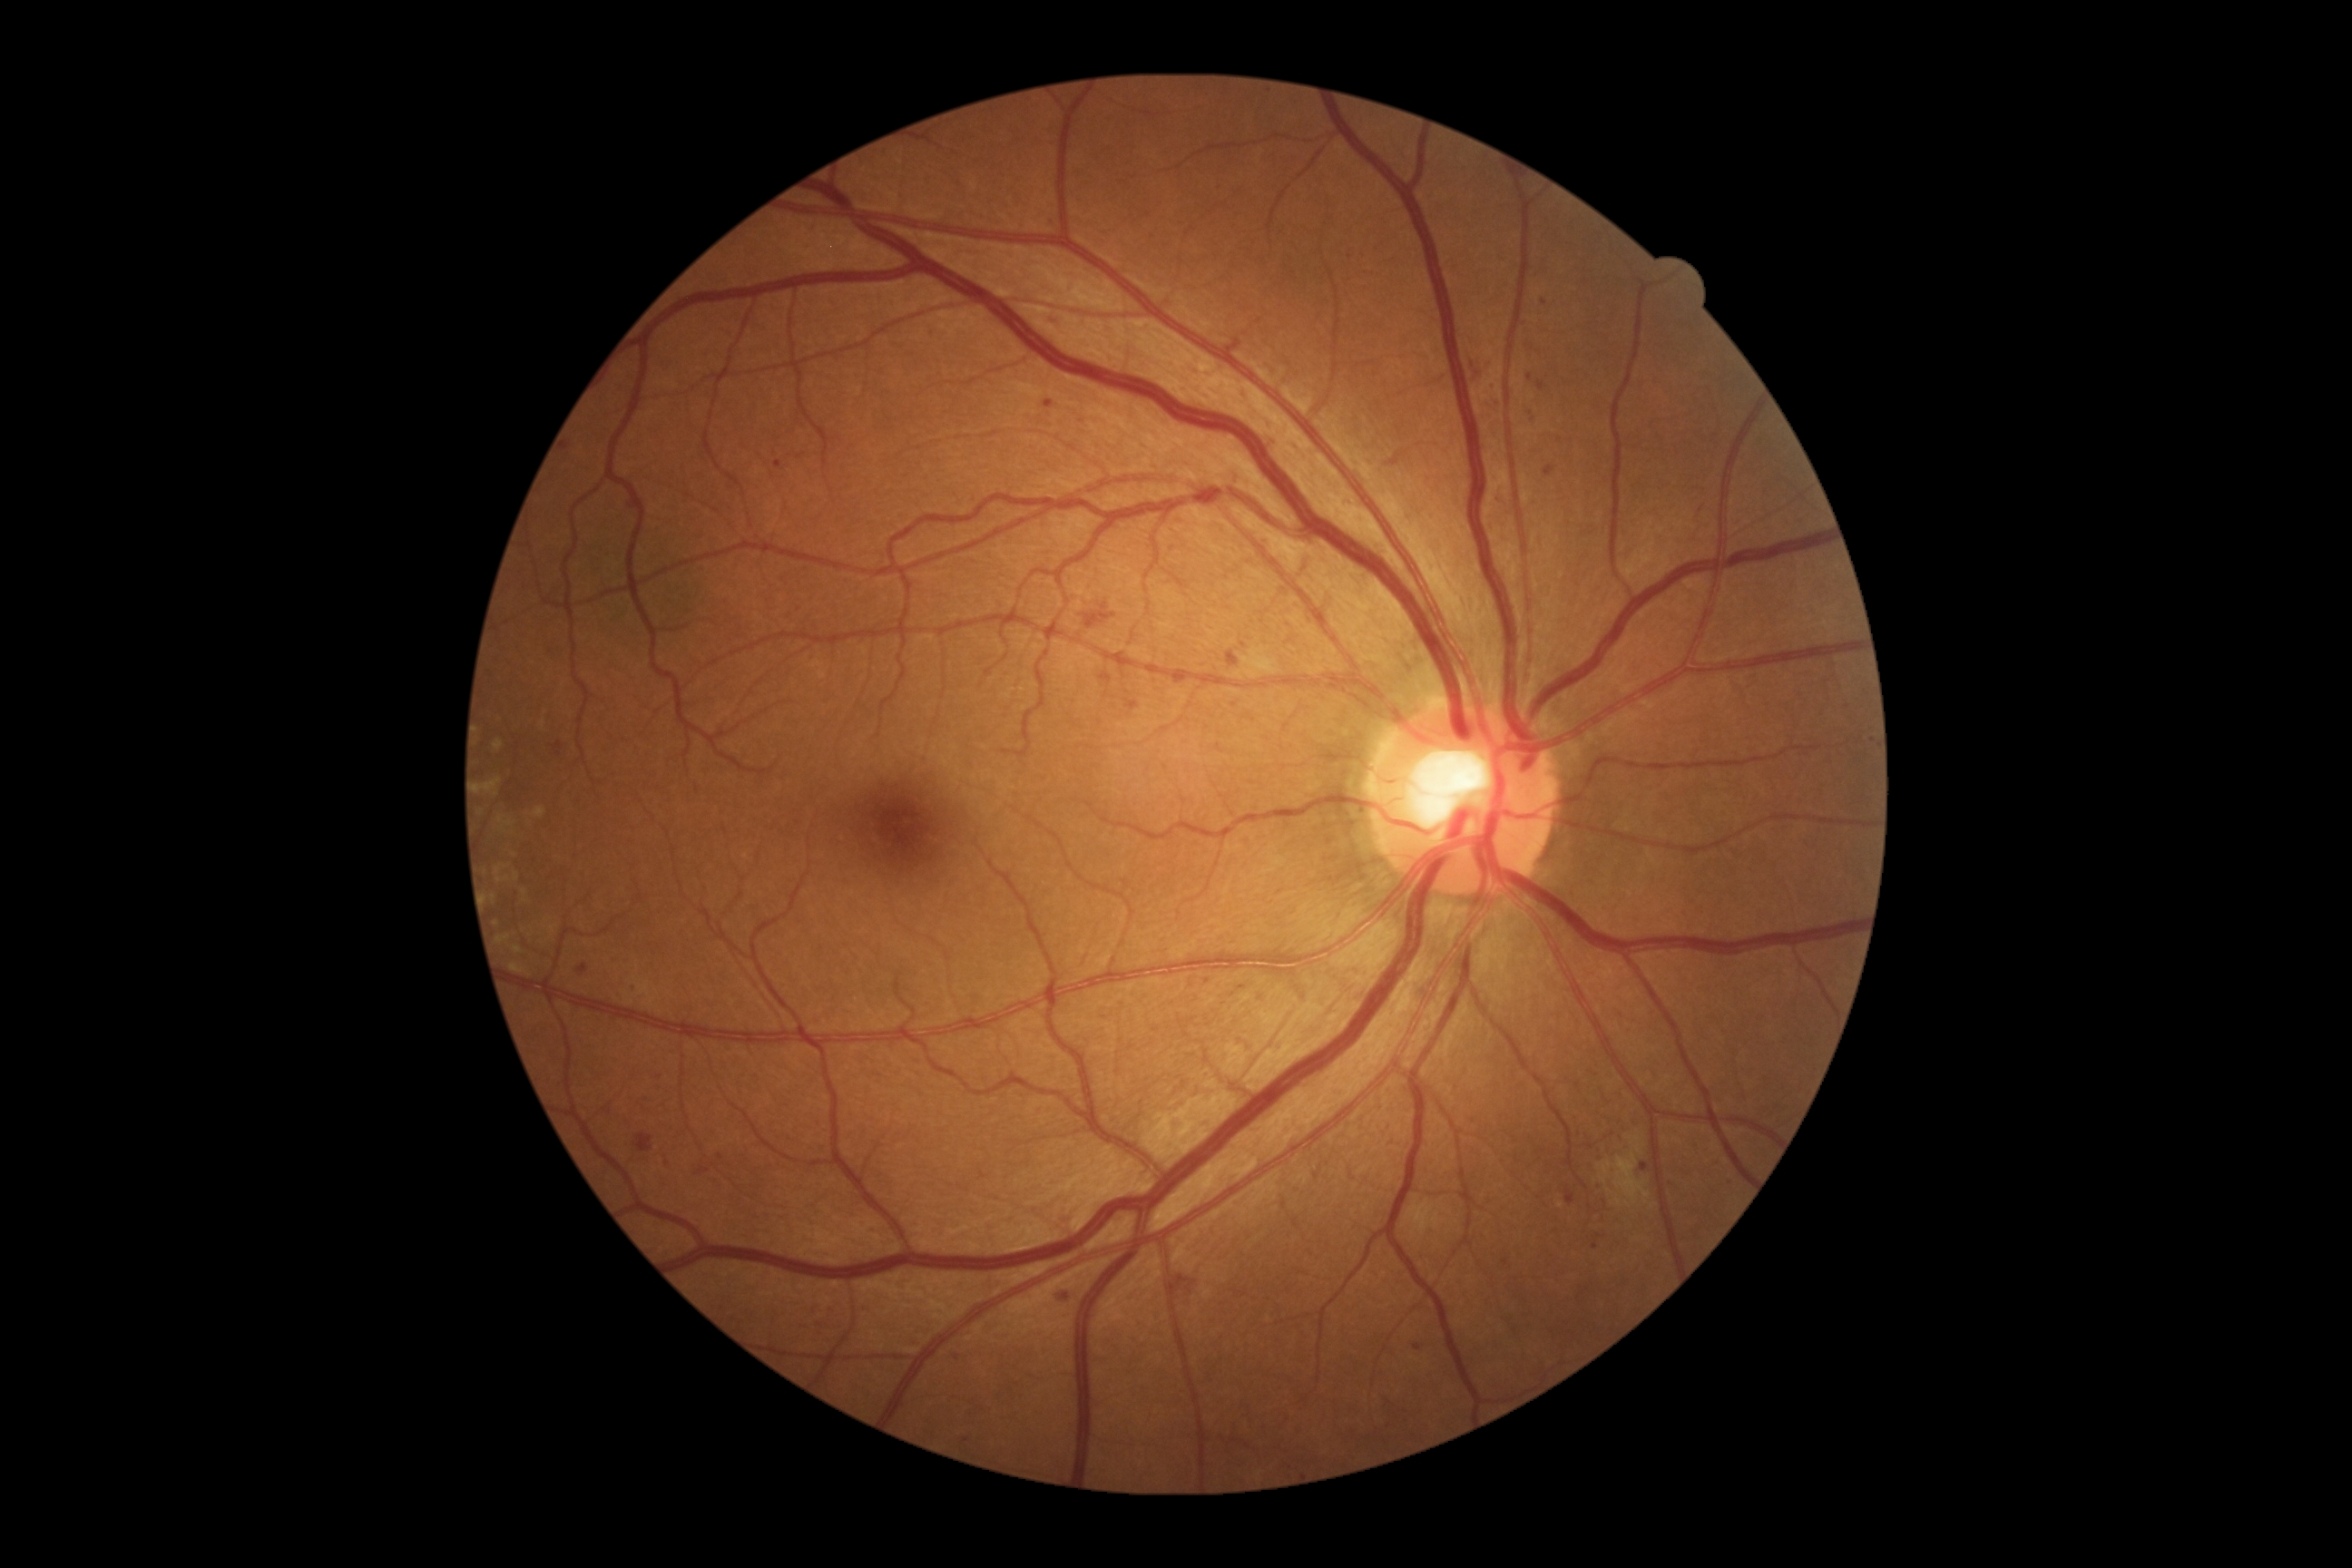 partial: true
dr_grade: 2
lesions:
  se:
    - x1=1596 y1=1153 x2=1651 y2=1206
    - x1=1611 y1=1199 x2=1623 y2=1208
    - x1=1627 y1=1135 x2=1643 y2=1155
  se_small_approx:
    - <point>1652, 1206</point>
    - <point>1628, 1205</point>
    - <point>1609, 1191</point>
  he:
    - x1=1469 y1=357 x2=1496 y2=384
    - x1=1386 y1=451 x2=1409 y2=467
    - x1=634 y1=1133 x2=654 y2=1153
    - x1=1083 y1=603 x2=1117 y2=629
    - x1=1173 y1=1271 x2=1199 y2=1304
  ma:
    - x1=1545 y1=466 x2=1554 y2=478
    - x1=1050 y1=313 x2=1066 y2=328
    - x1=1099 y1=674 x2=1112 y2=683
    - x1=1565 y1=1190 x2=1574 y2=1204
    - x1=1055 y1=1289 x2=1070 y2=1304
    - x1=1493 y1=395 x2=1502 y2=406
    - x1=1592 y1=1244 x2=1600 y2=1250
    - x1=1538 y1=382 x2=1545 y2=391
    - x1=1126 y1=700 x2=1141 y2=710
  ma_small_approx:
    - <point>1531, 377</point>
    - <point>967, 1440</point>
    - <point>1645, 1167</point>
    - <point>1281, 893</point>
  ex:
    - x1=514 y1=872 x2=520 y2=881
    - x1=514 y1=946 x2=522 y2=954
    - x1=480 y1=778 x2=502 y2=798
    - x1=493 y1=741 x2=504 y2=752
    - x1=534 y1=807 x2=547 y2=819
    - x1=496 y1=867 x2=504 y2=876
    - x1=498 y1=936 x2=511 y2=945
    - x1=549 y1=926 x2=558 y2=934
    - x1=511 y1=963 x2=531 y2=977
    - x1=498 y1=818 x2=513 y2=827
    - x1=540 y1=721 x2=547 y2=729
  ex_small_approx:
    - <point>496, 923</point>
    - <point>494, 898</point>
    - <point>500, 880</point>
    - <point>514, 856</point>
    - <point>508, 879</point>
    - <point>524, 893</point>